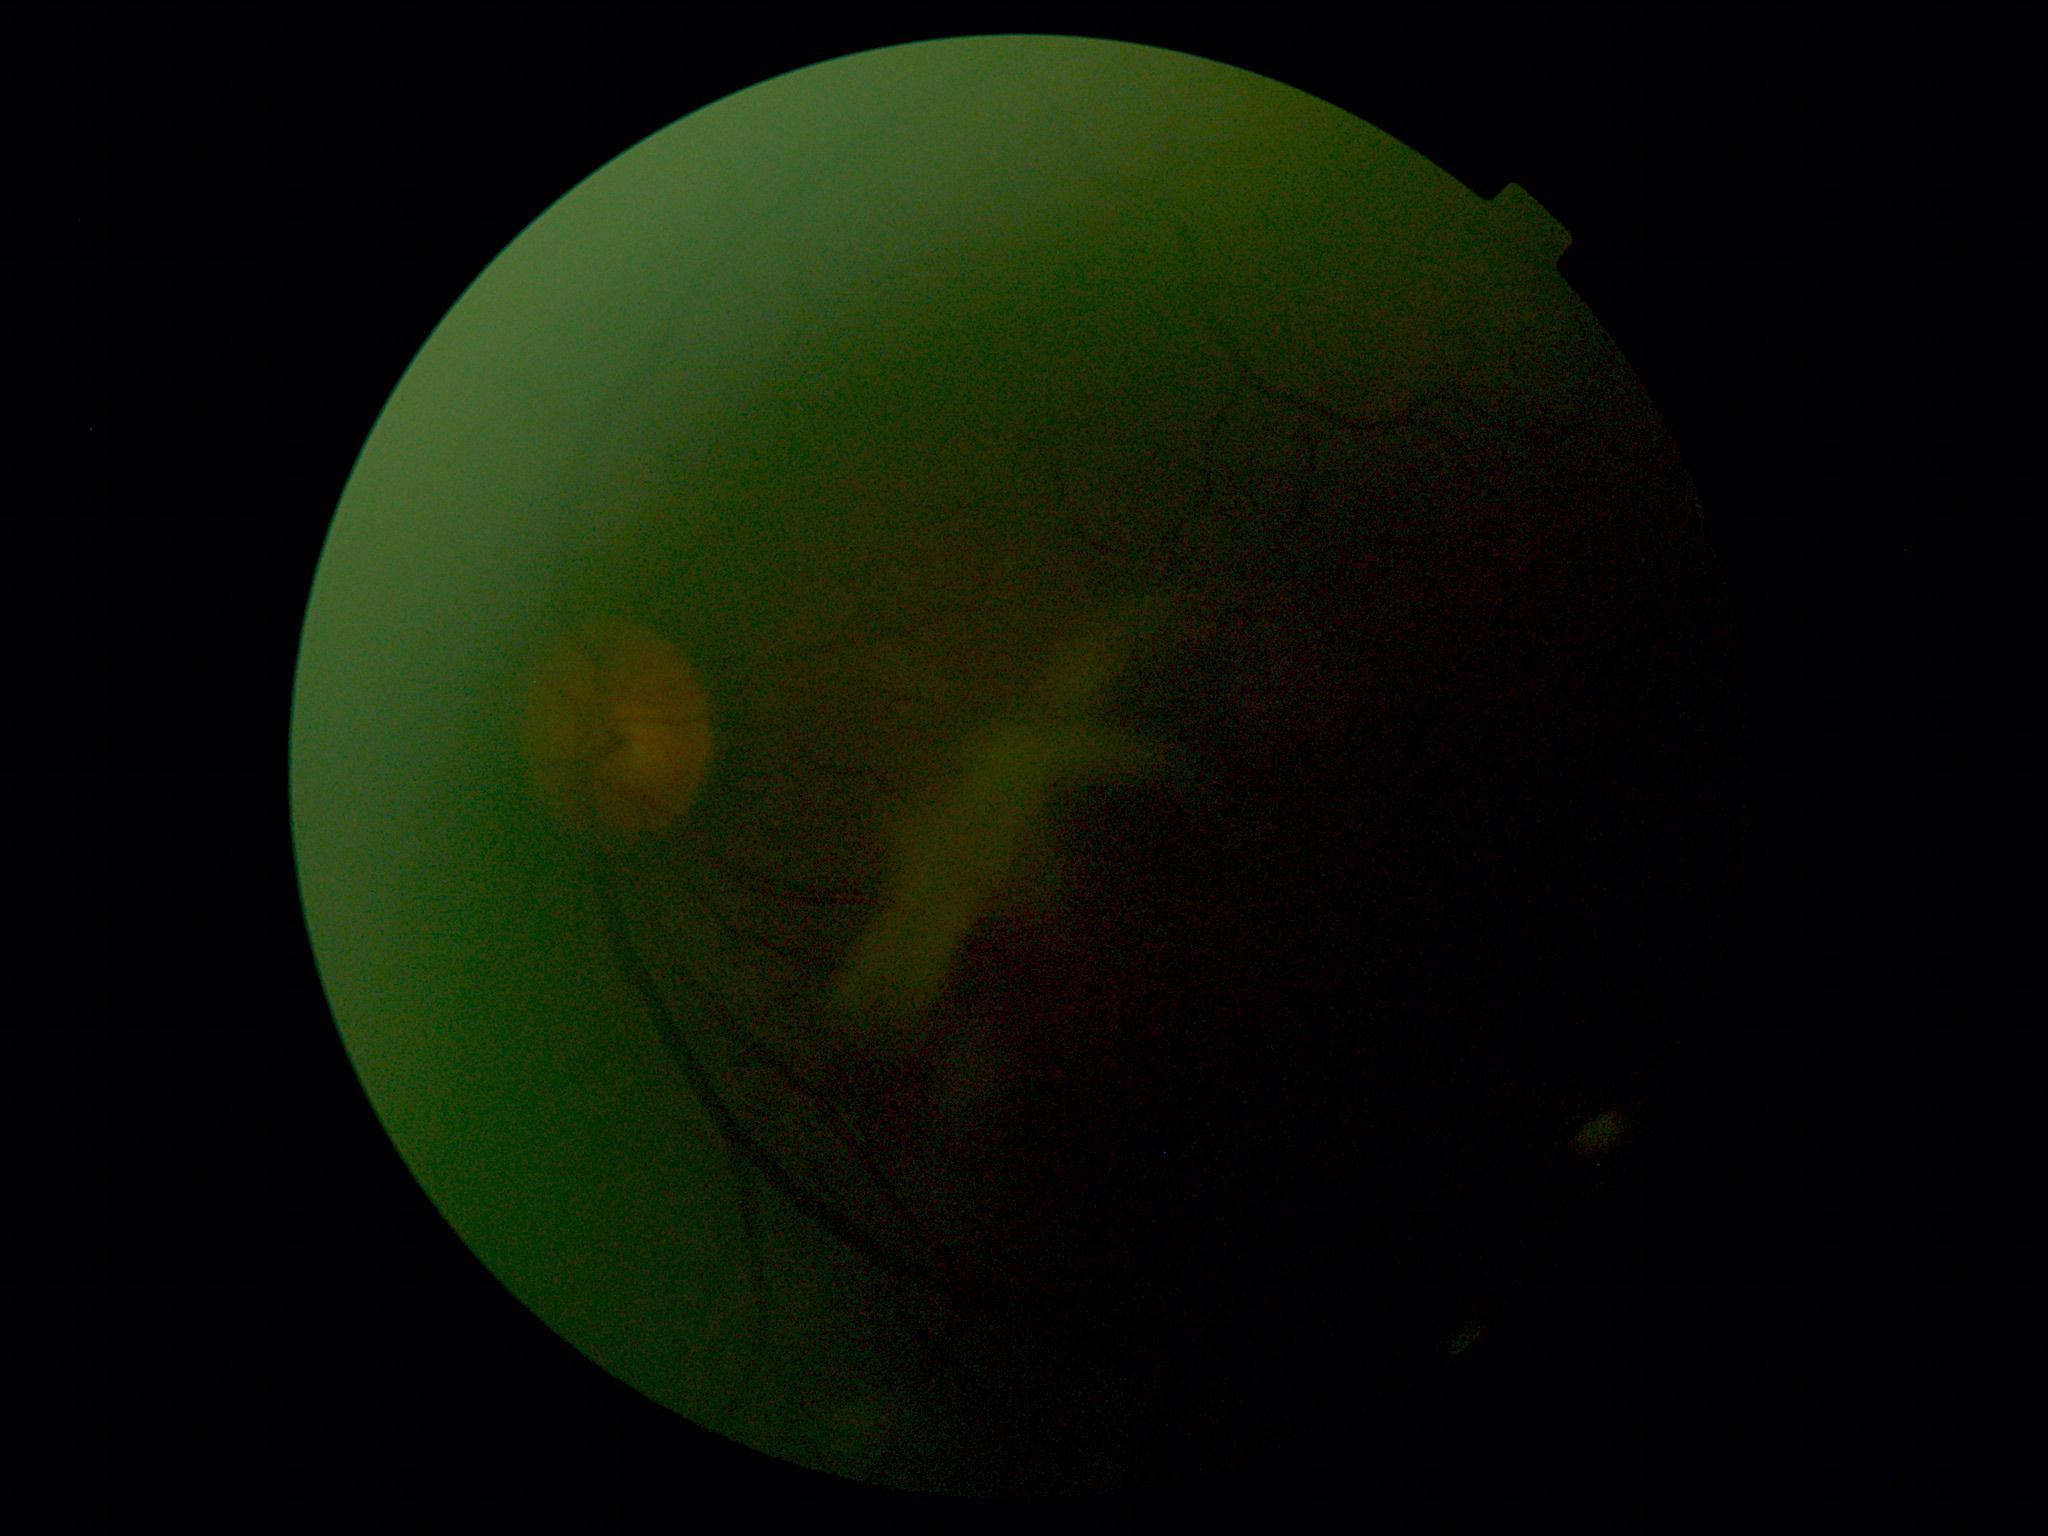 The image cannot be graded for diabetic retinopathy. Diabetic retinopathy (DR): ungradable due to poor image quality.